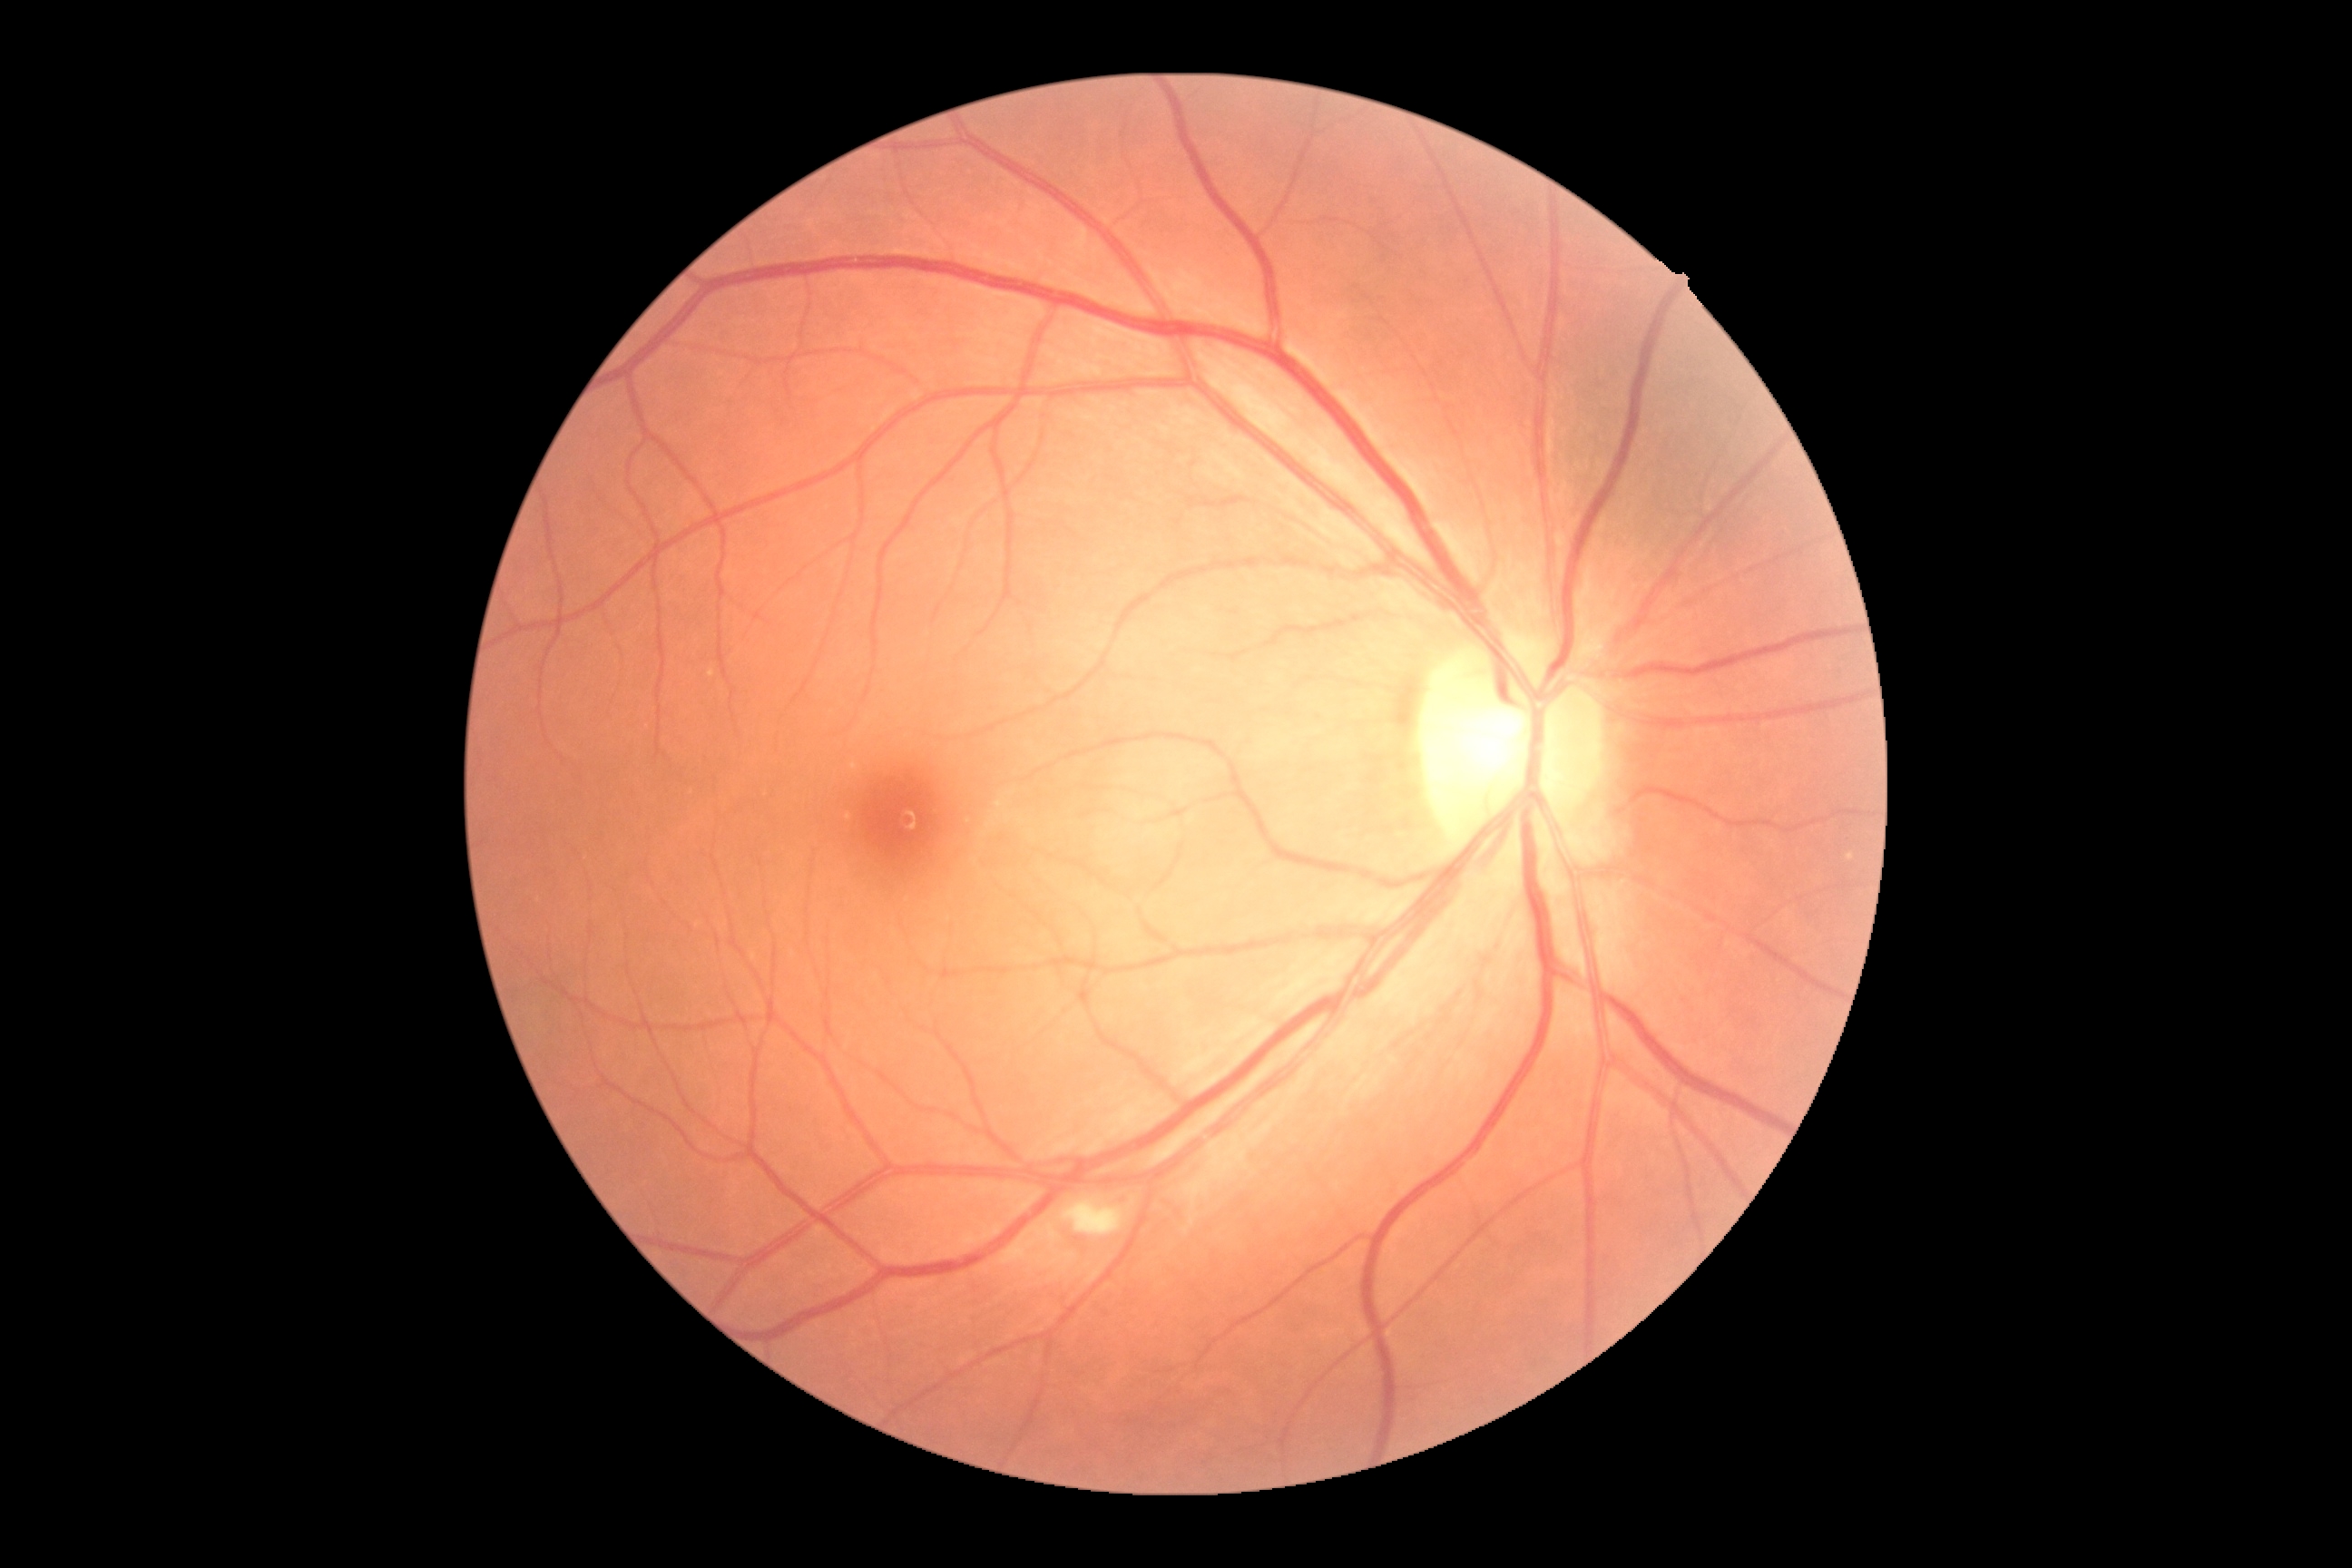 {
  "dr_grade": "2"
}